45° FOV — 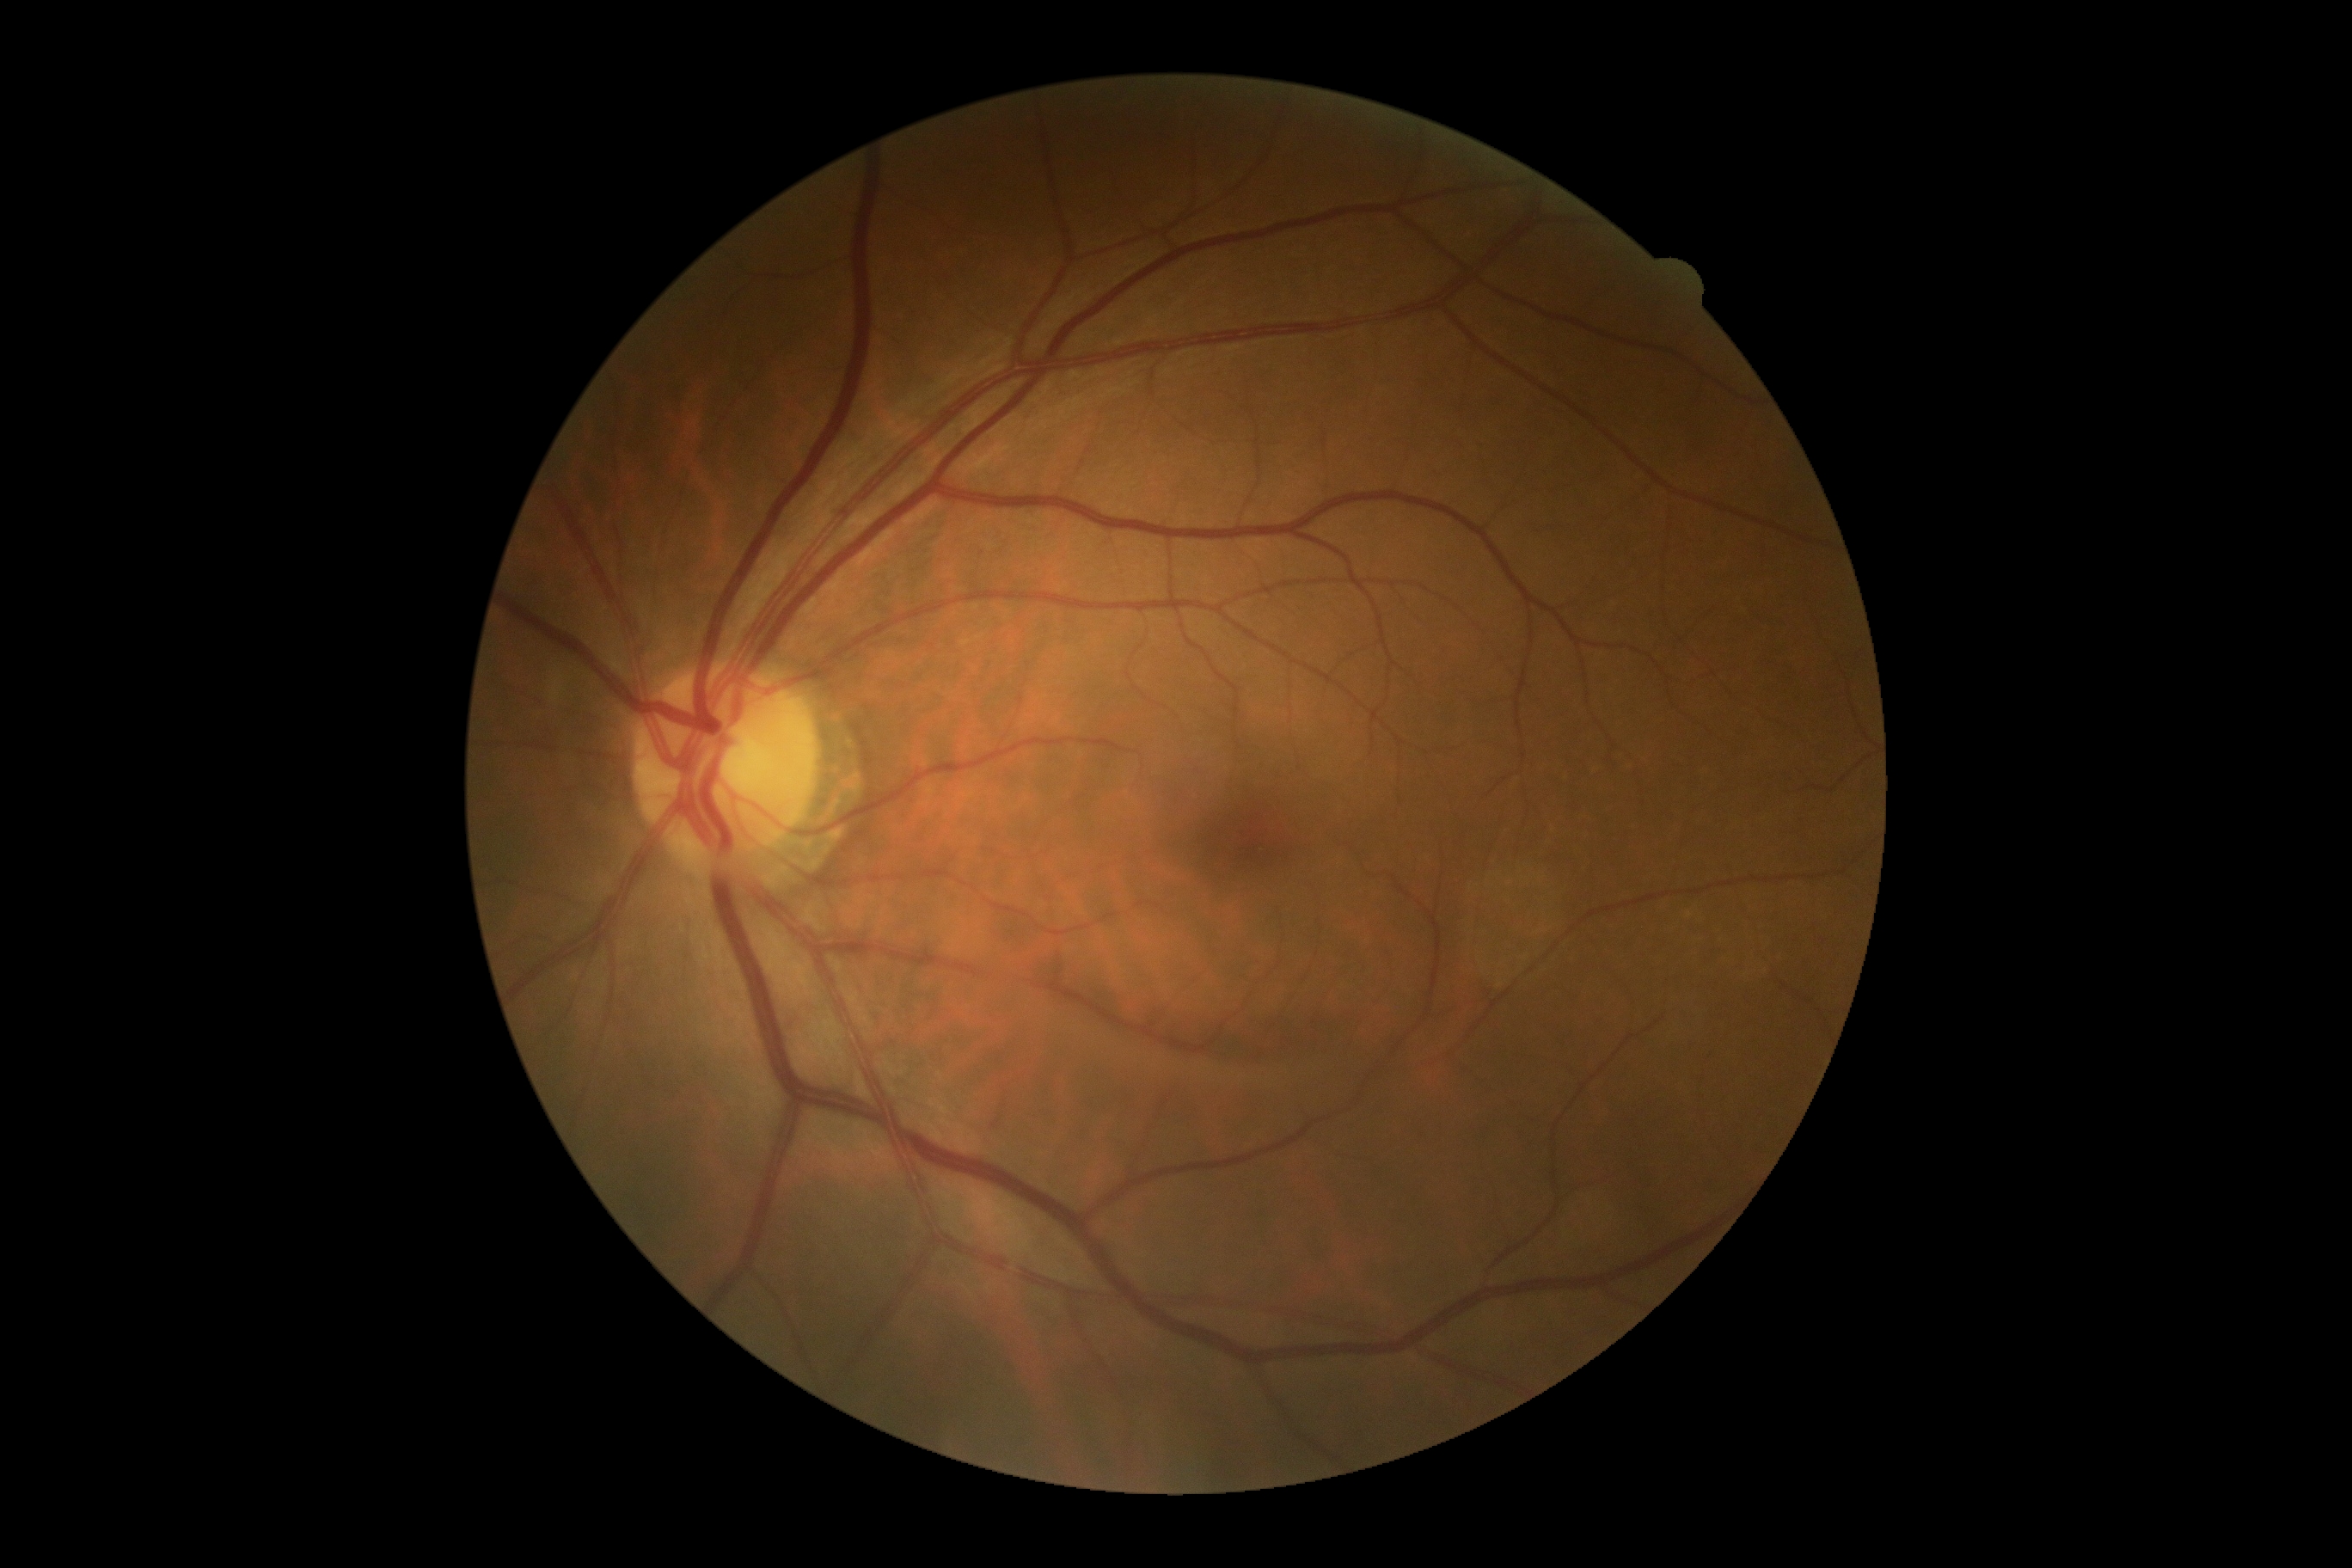 DR grade=0.